Fundus photo
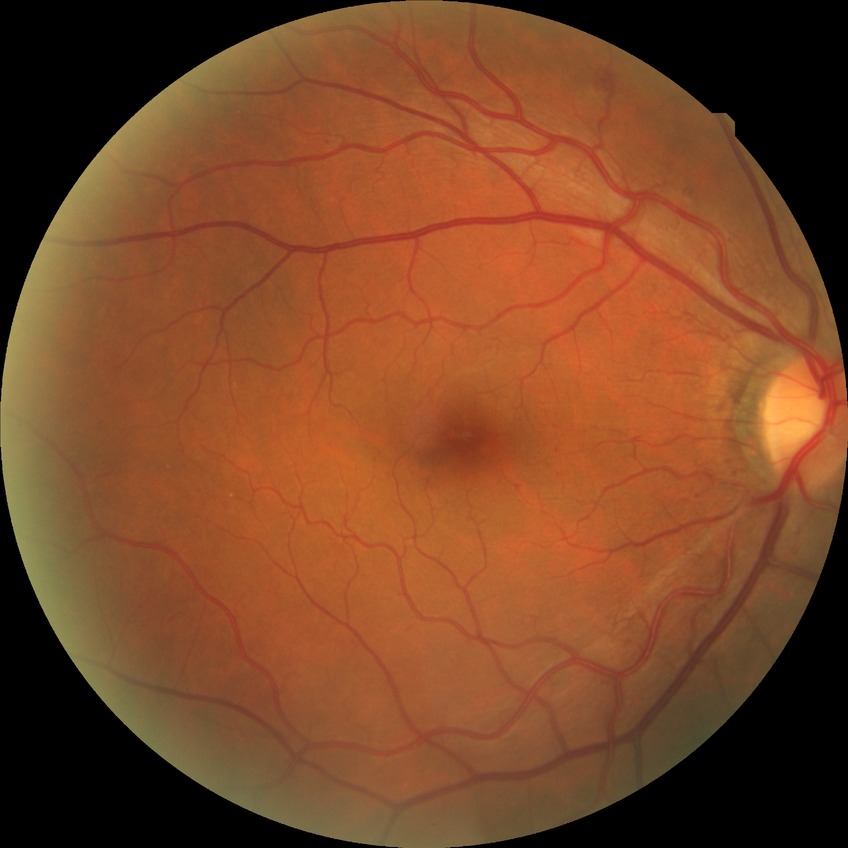
Diabetic retinopathy (DR): simple diabetic retinopathy (SDR).